Image size 1659x2212. Camera: Remidio FOP fundus camera. CFP — 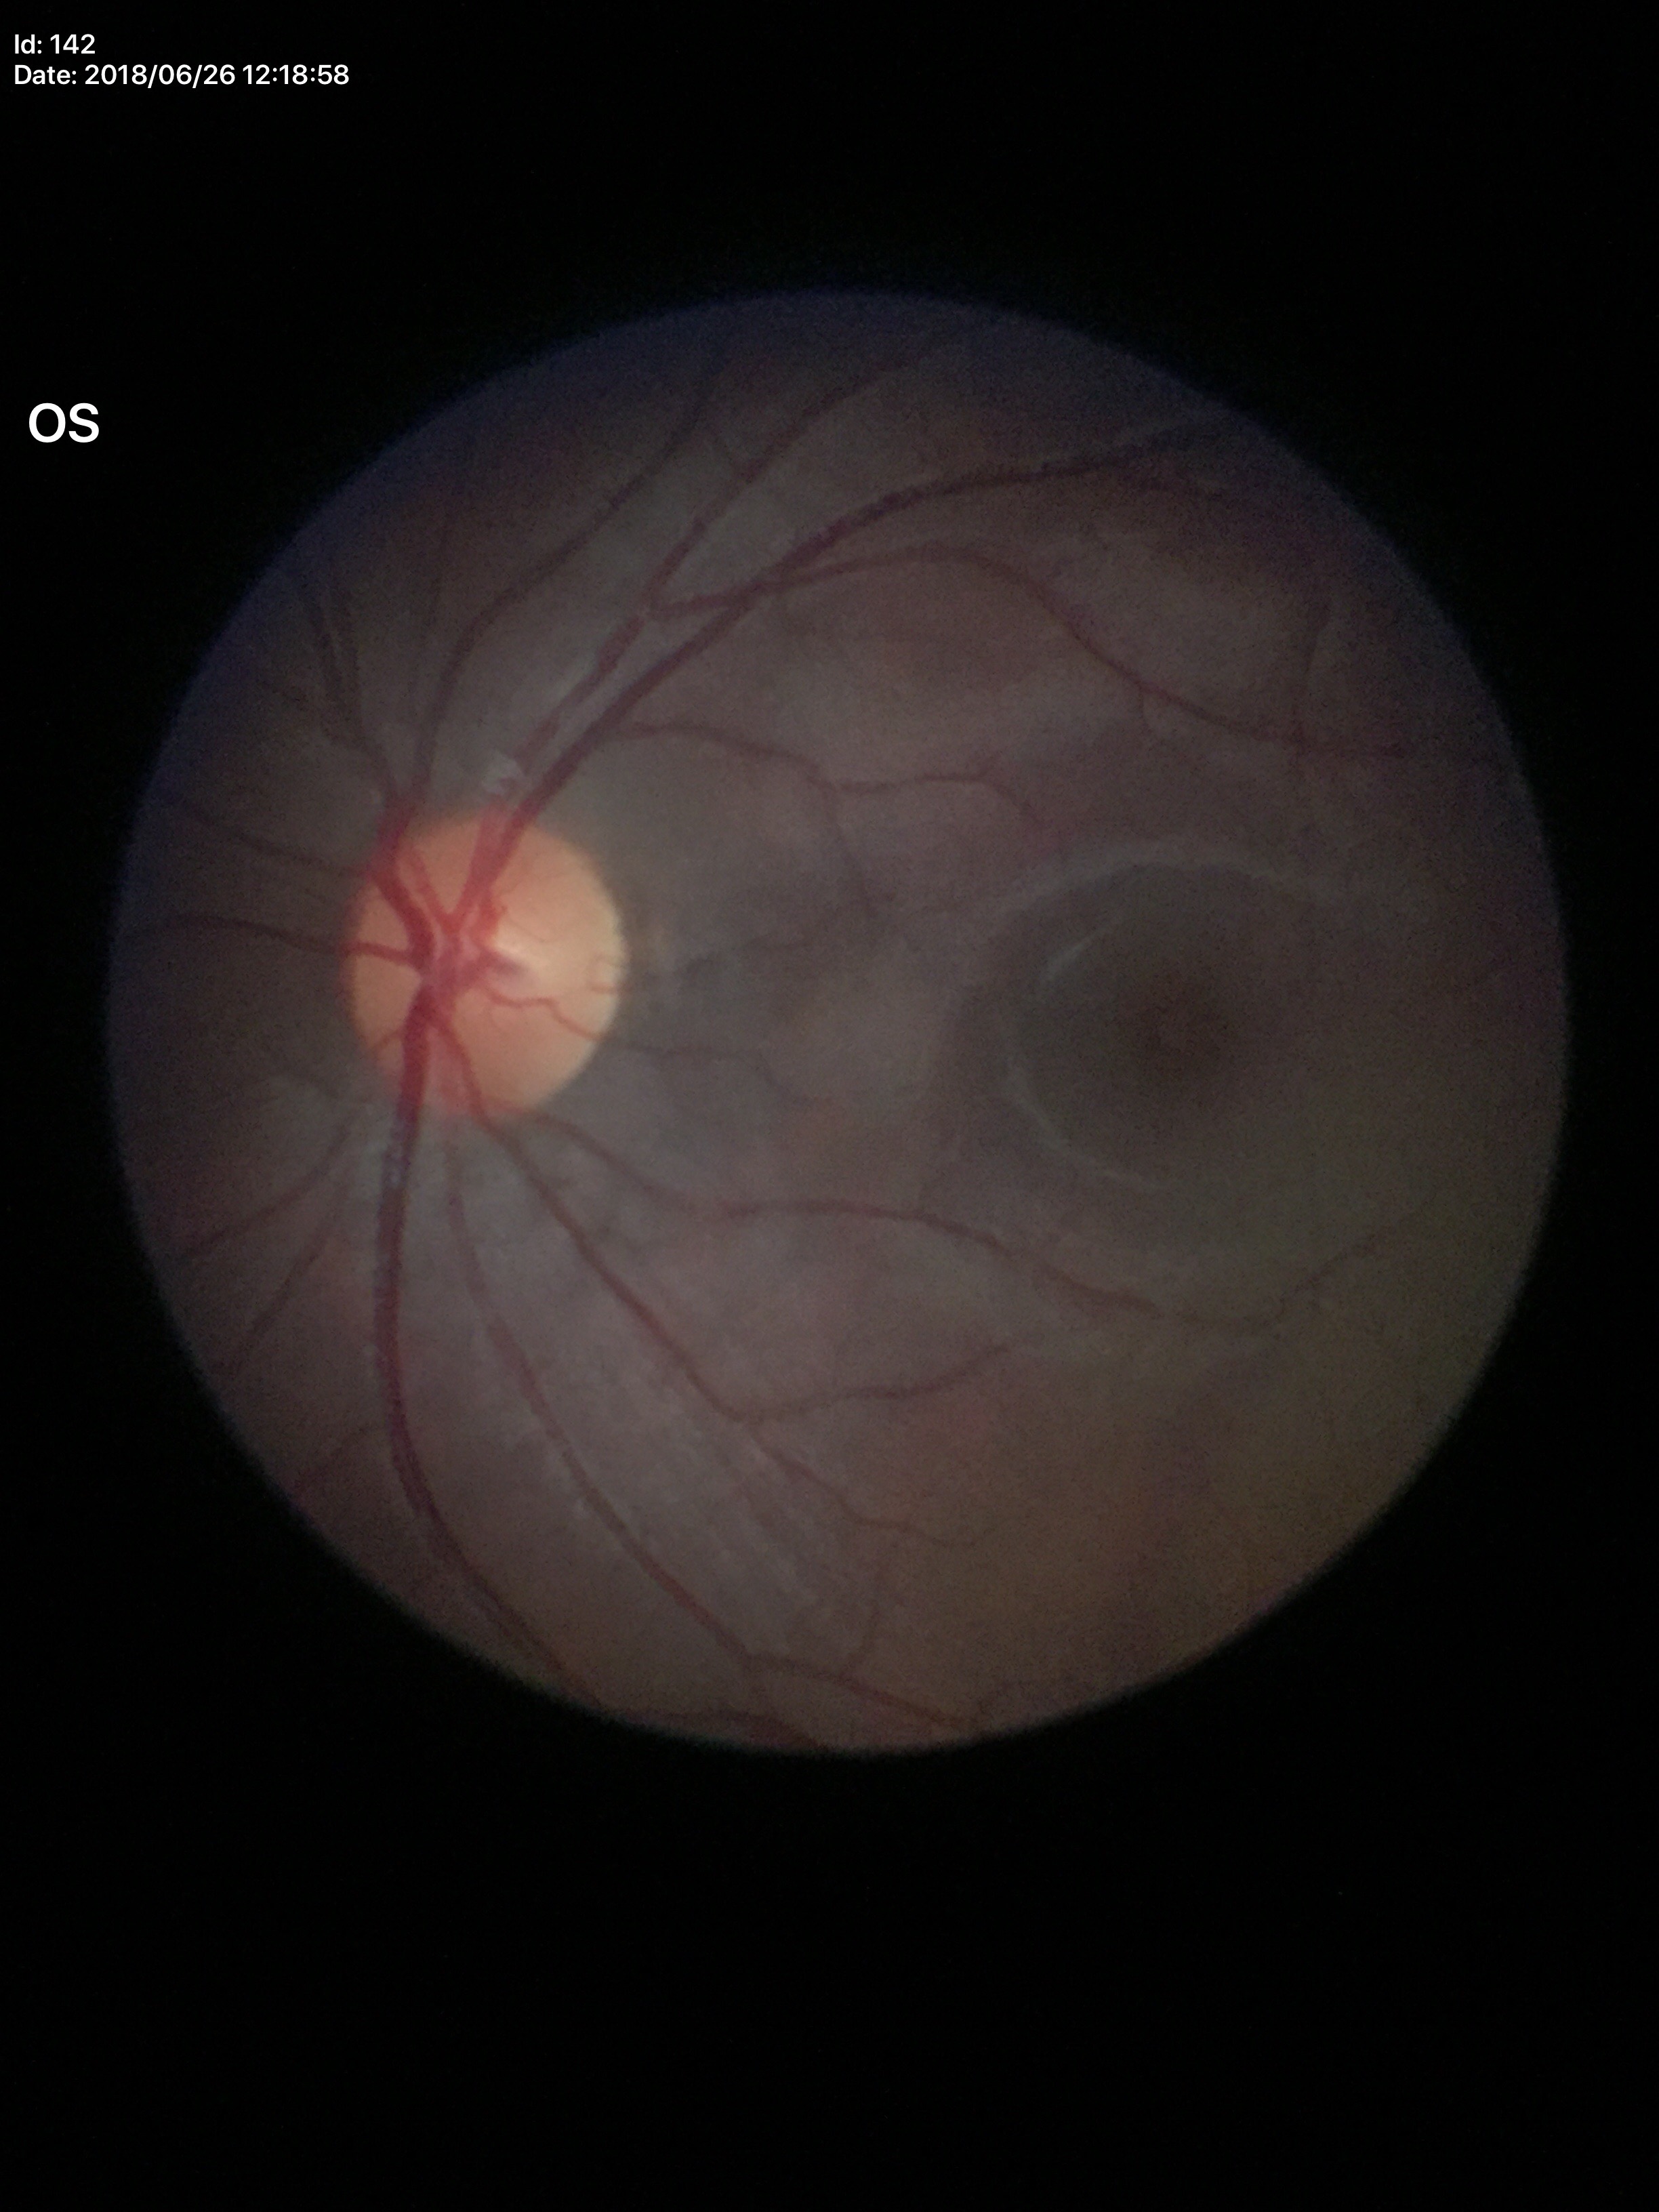

No glaucomatous optic neuropathy.
VCDR is 0.46.
ACDR: 0.22.